NIDEK AFC-230 fundus camera. Posterior pole photograph: 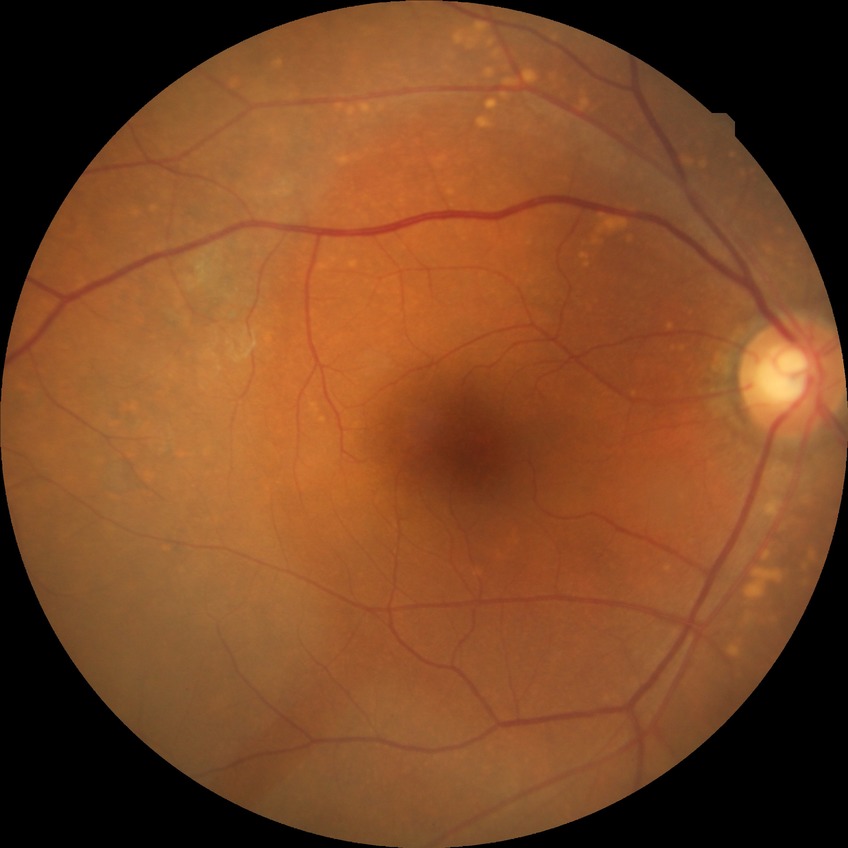 Diabetic retinopathy (DR): NDR (no diabetic retinopathy).